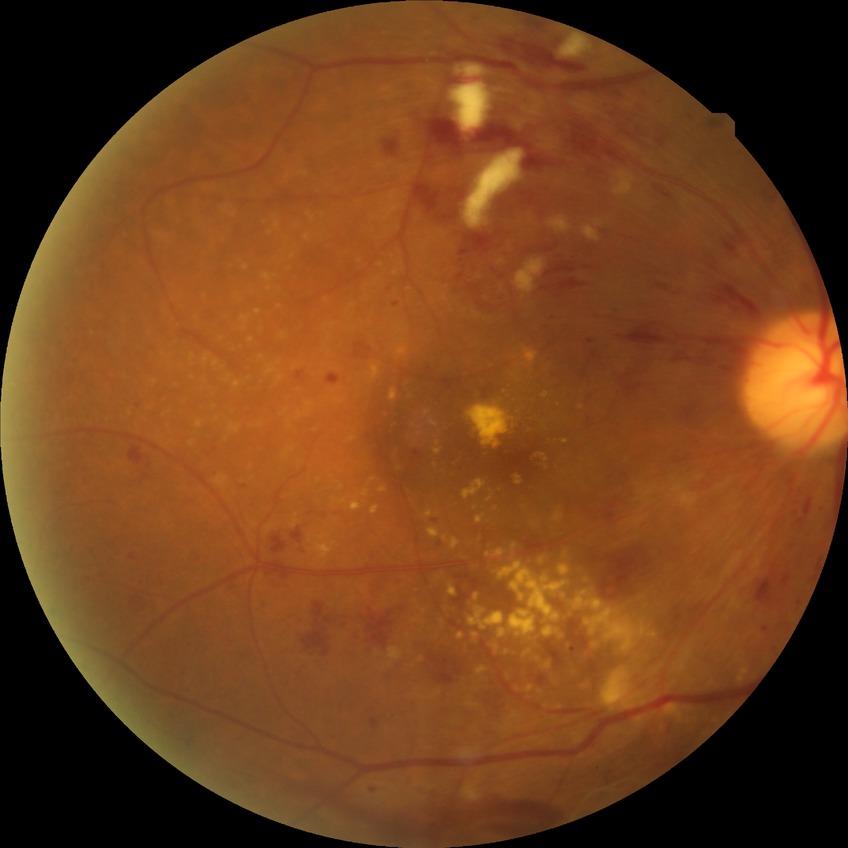
modified Davis grading = pre-proliferative diabetic retinopathy.